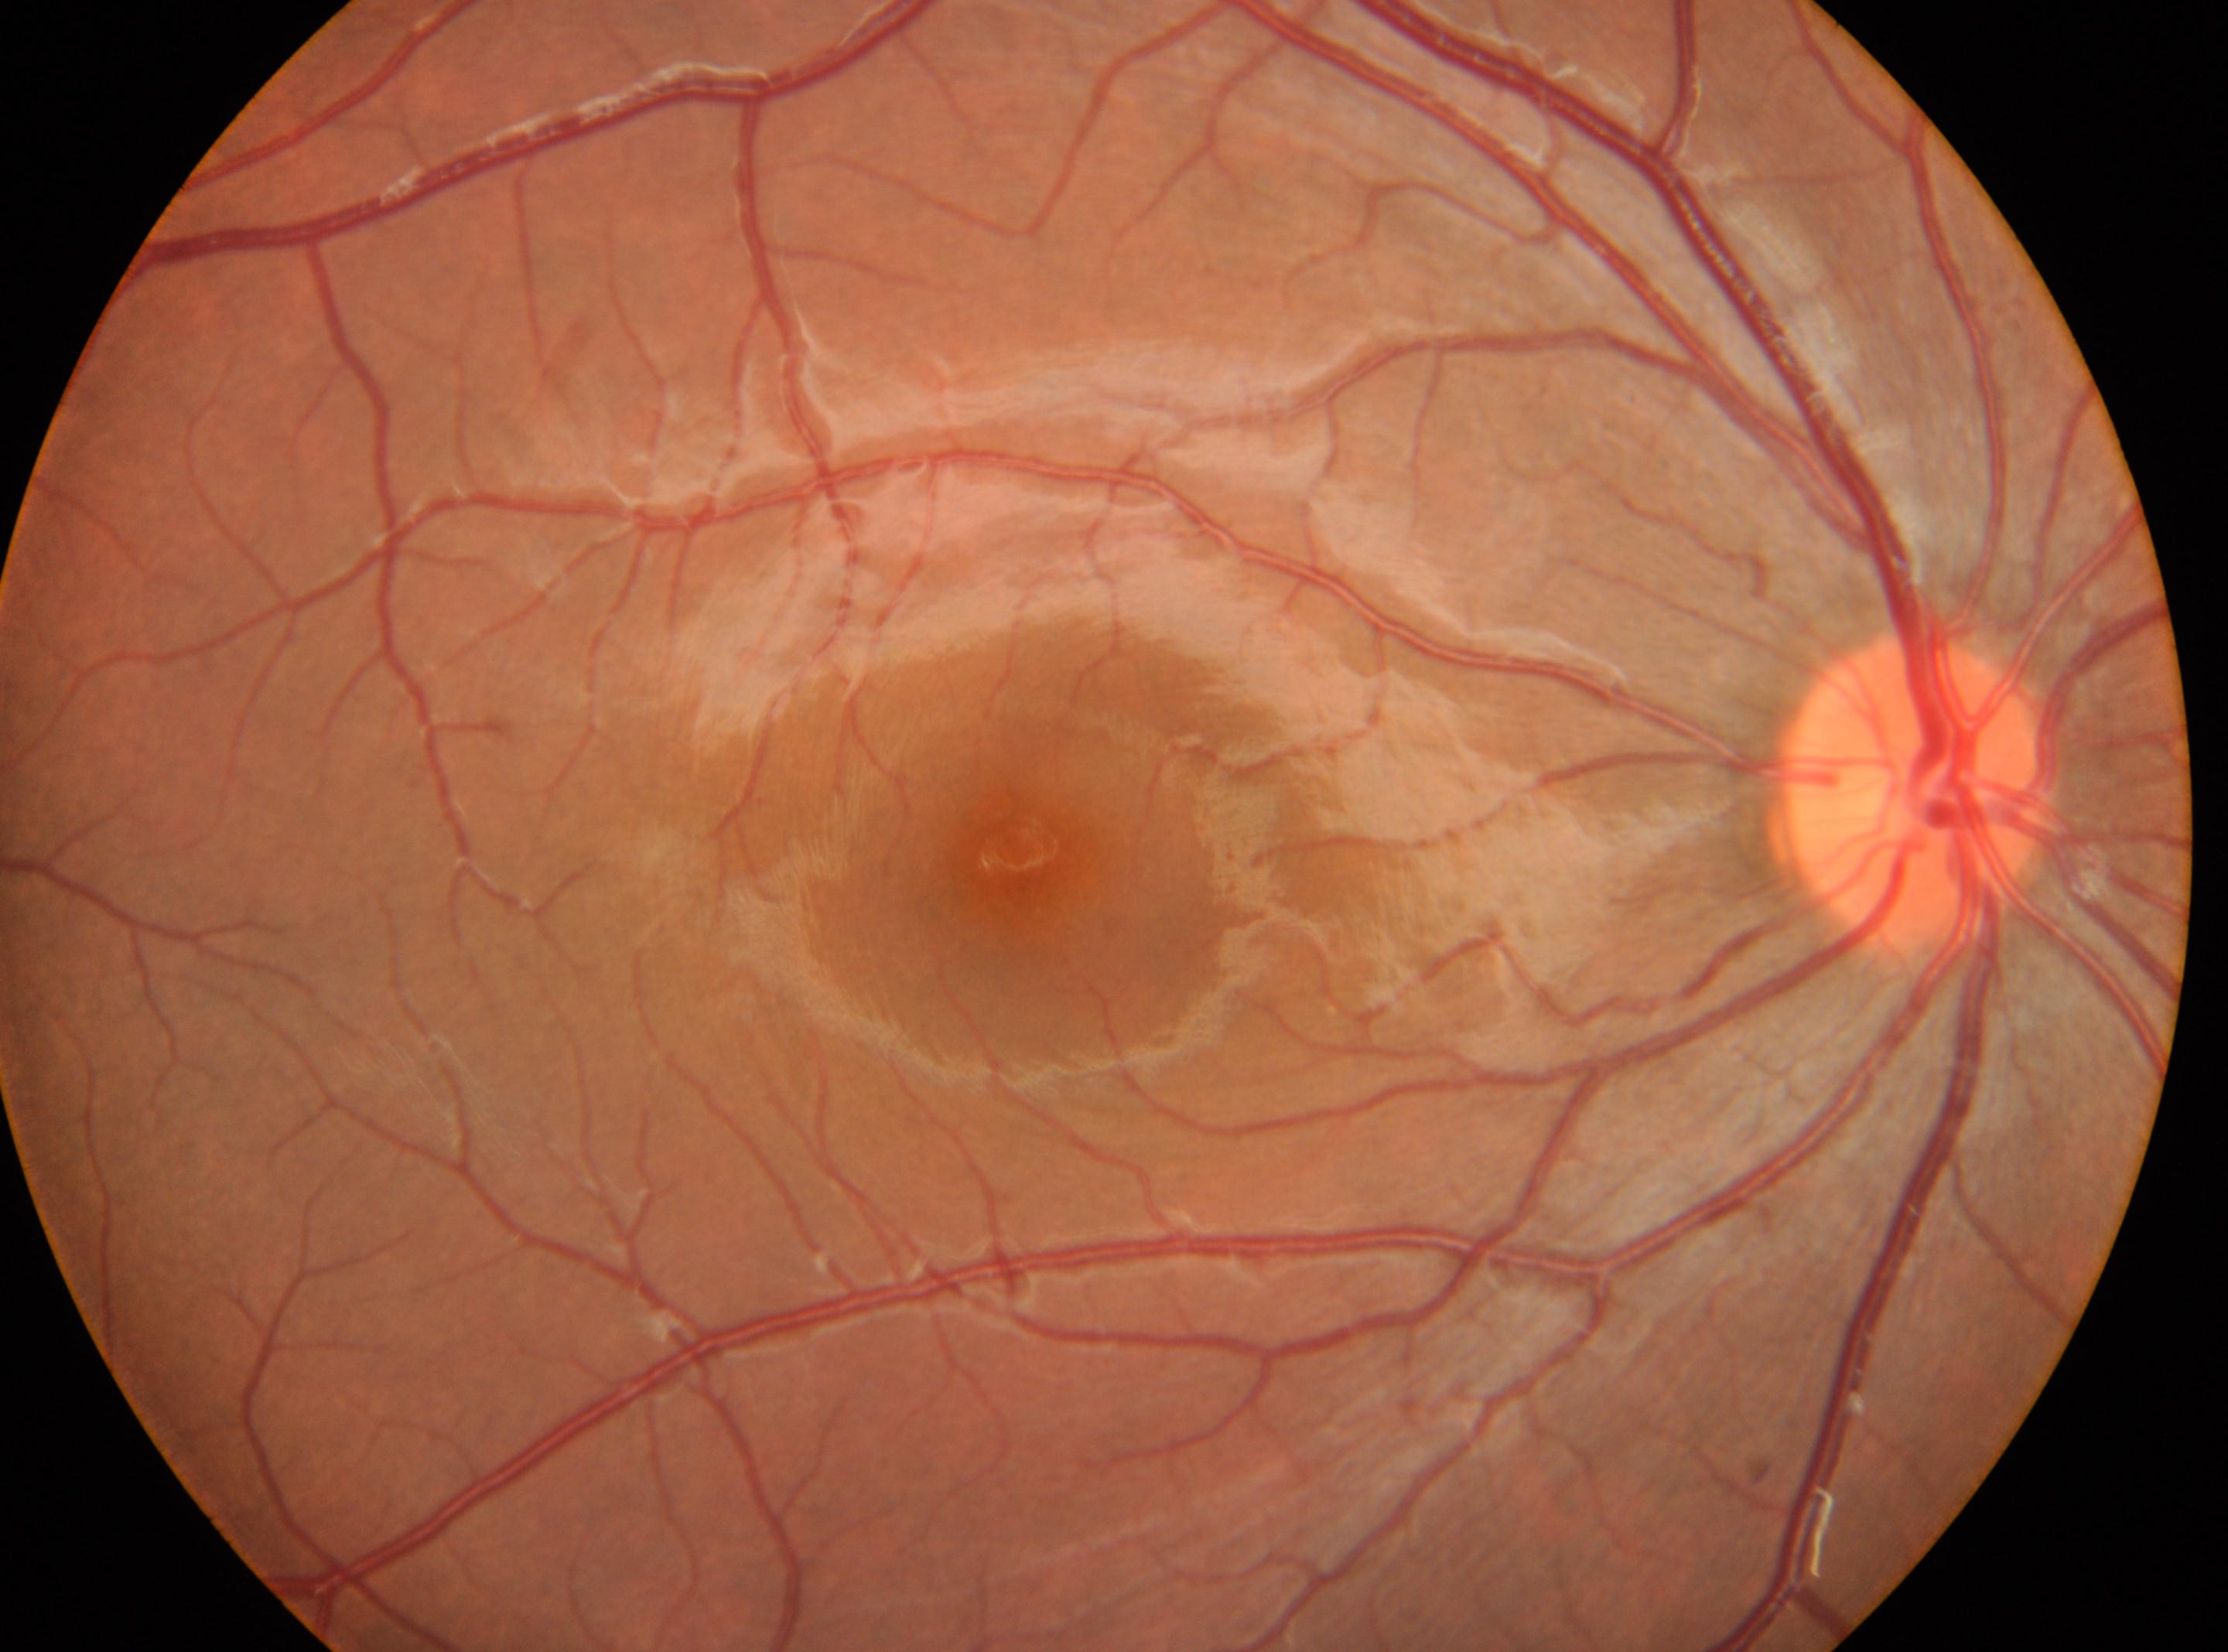
diabetic retinopathy severity: 0/4, optic nerve head: (1917,794), macular center: (1026,860), DR impression: No signs of diabetic retinopathy, laterality: right.